Modified Davis classification: 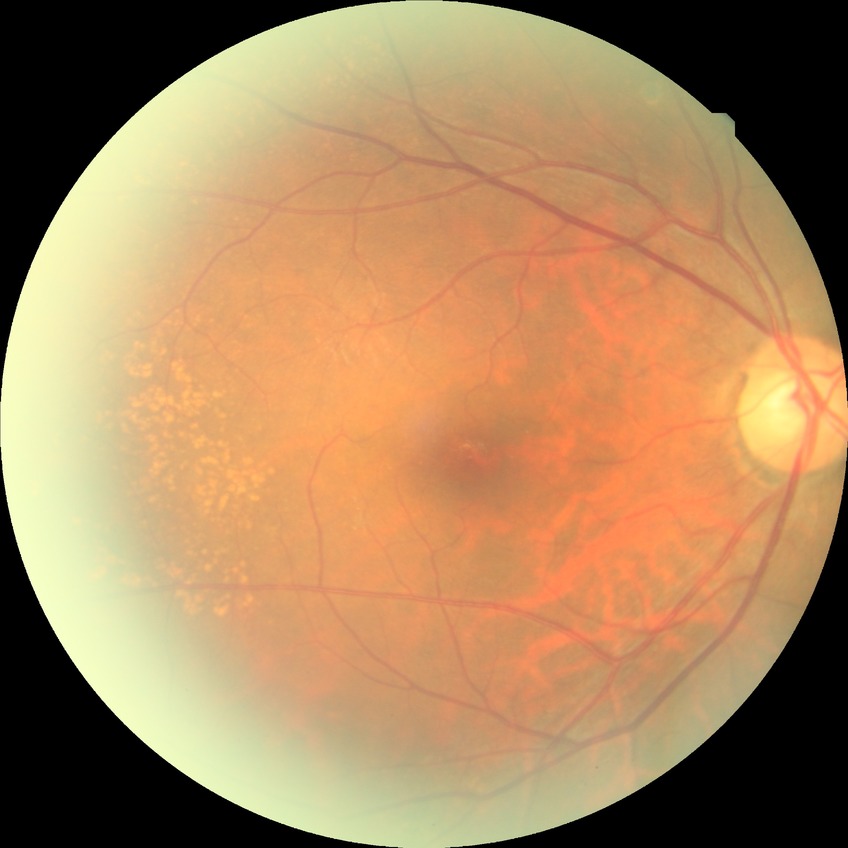

diabetic retinopathy stage: no diabetic retinopathy.